Acquired on the Clarity RetCam 3; infant wide-field fundus photograph:
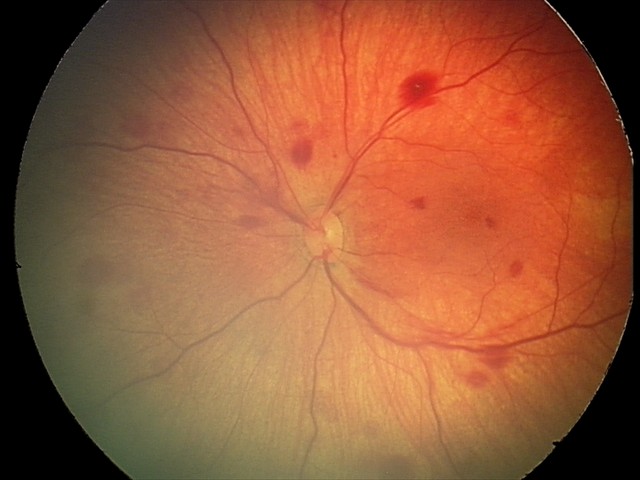 Finding: retinal hemorrhages.